Camera: NIDEK AFC-230 · 848x848px · diabetic retinopathy graded by the modified Davis classification
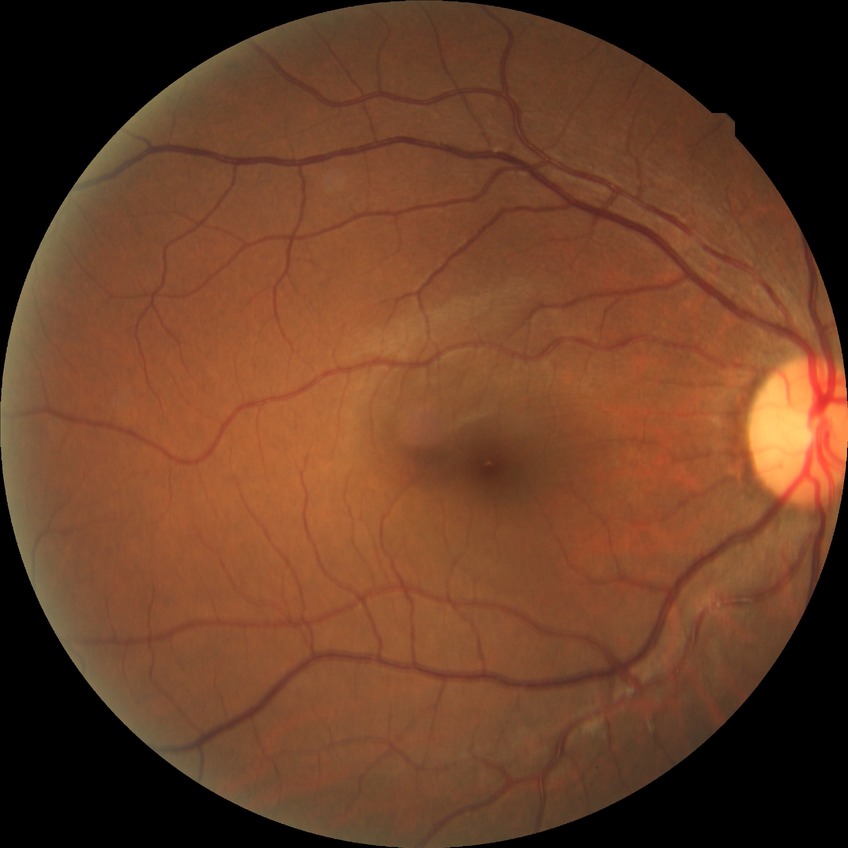 diabetic retinopathy (DR) = no diabetic retinopathy (NDR)